Retinal fundus photograph; FOV: 45 degrees — 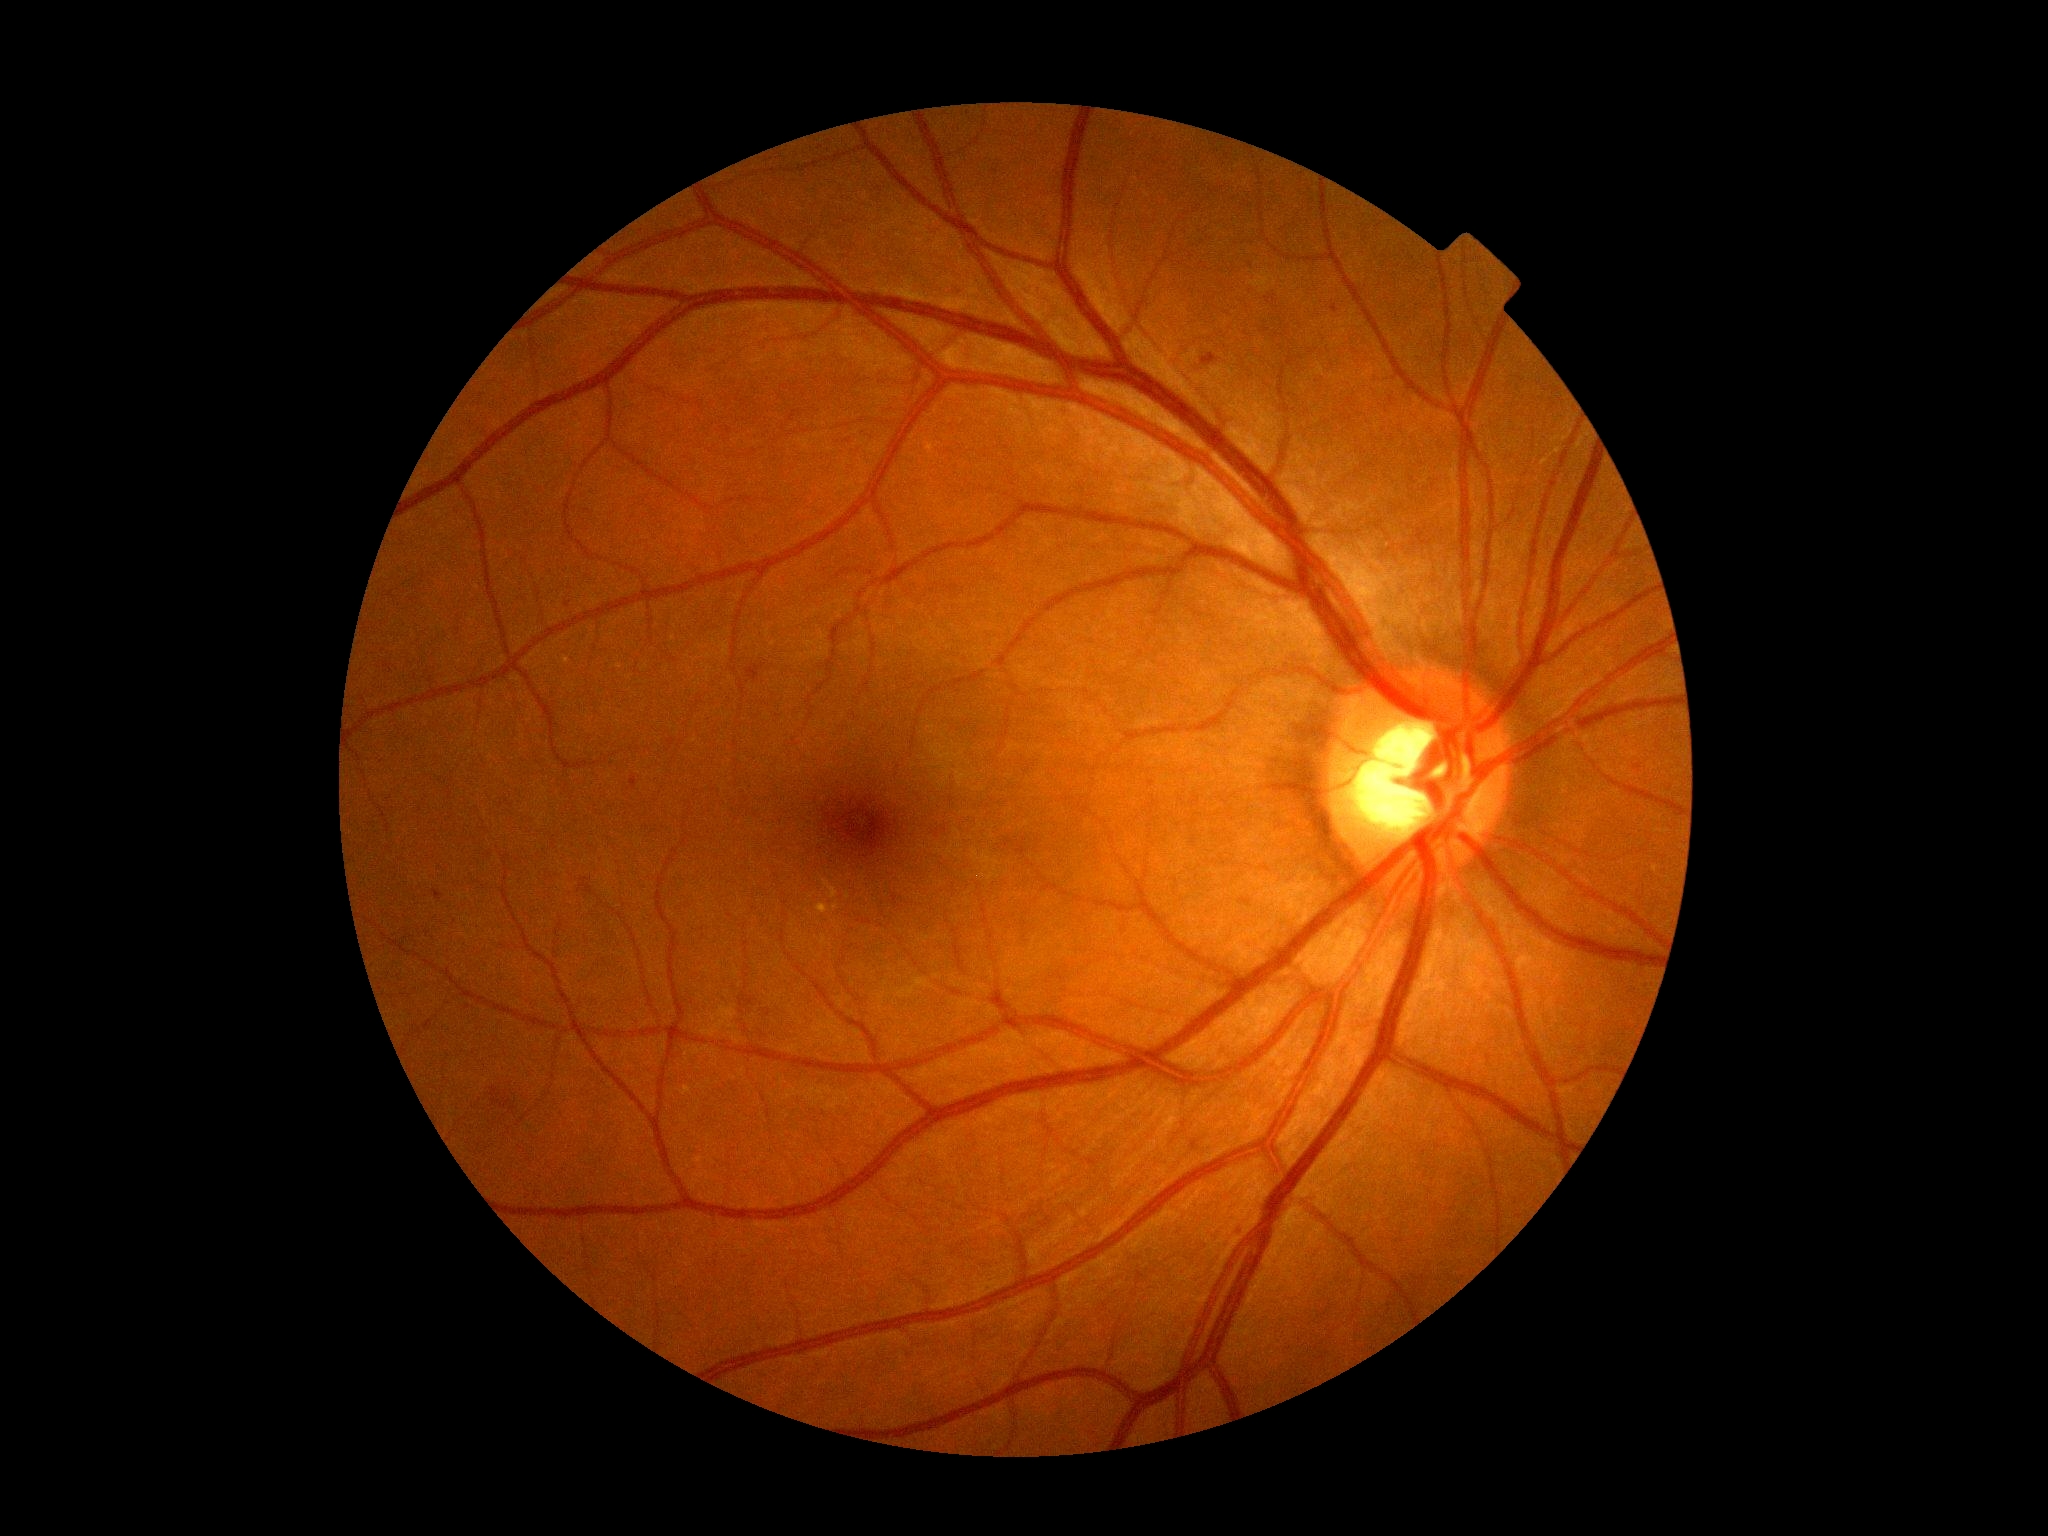
Diabetic retinopathy (DR) is grade 2
A subset of detected lesions:
microaneurysms (MAs) (partial): bbox=[1240, 898, 1252, 906], bbox=[747, 665, 766, 682], bbox=[1332, 306, 1340, 314], bbox=[456, 629, 461, 637], bbox=[1634, 766, 1642, 772], bbox=[739, 995, 755, 1008], bbox=[1202, 353, 1220, 367], bbox=[631, 776, 637, 791], bbox=[1230, 1224, 1239, 1235], bbox=[433, 890, 444, 902]
Additional small MAs near (1194,1146), (568,605)
hemorrhages (HEs): bbox=[490, 1089, 522, 1123]
hard exudates (EXs) (partial): bbox=[833, 903, 840, 911], bbox=[816, 903, 831, 914], bbox=[823, 880, 839, 899]
soft exudates (SEs): not present